Color fundus photograph
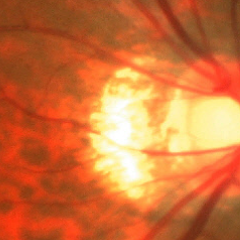
Findings consistent with glaucoma. The image shows early glaucomatous changes.